CFP. Captured on a Remidio FOP fundus camera. Image size 1659x2212
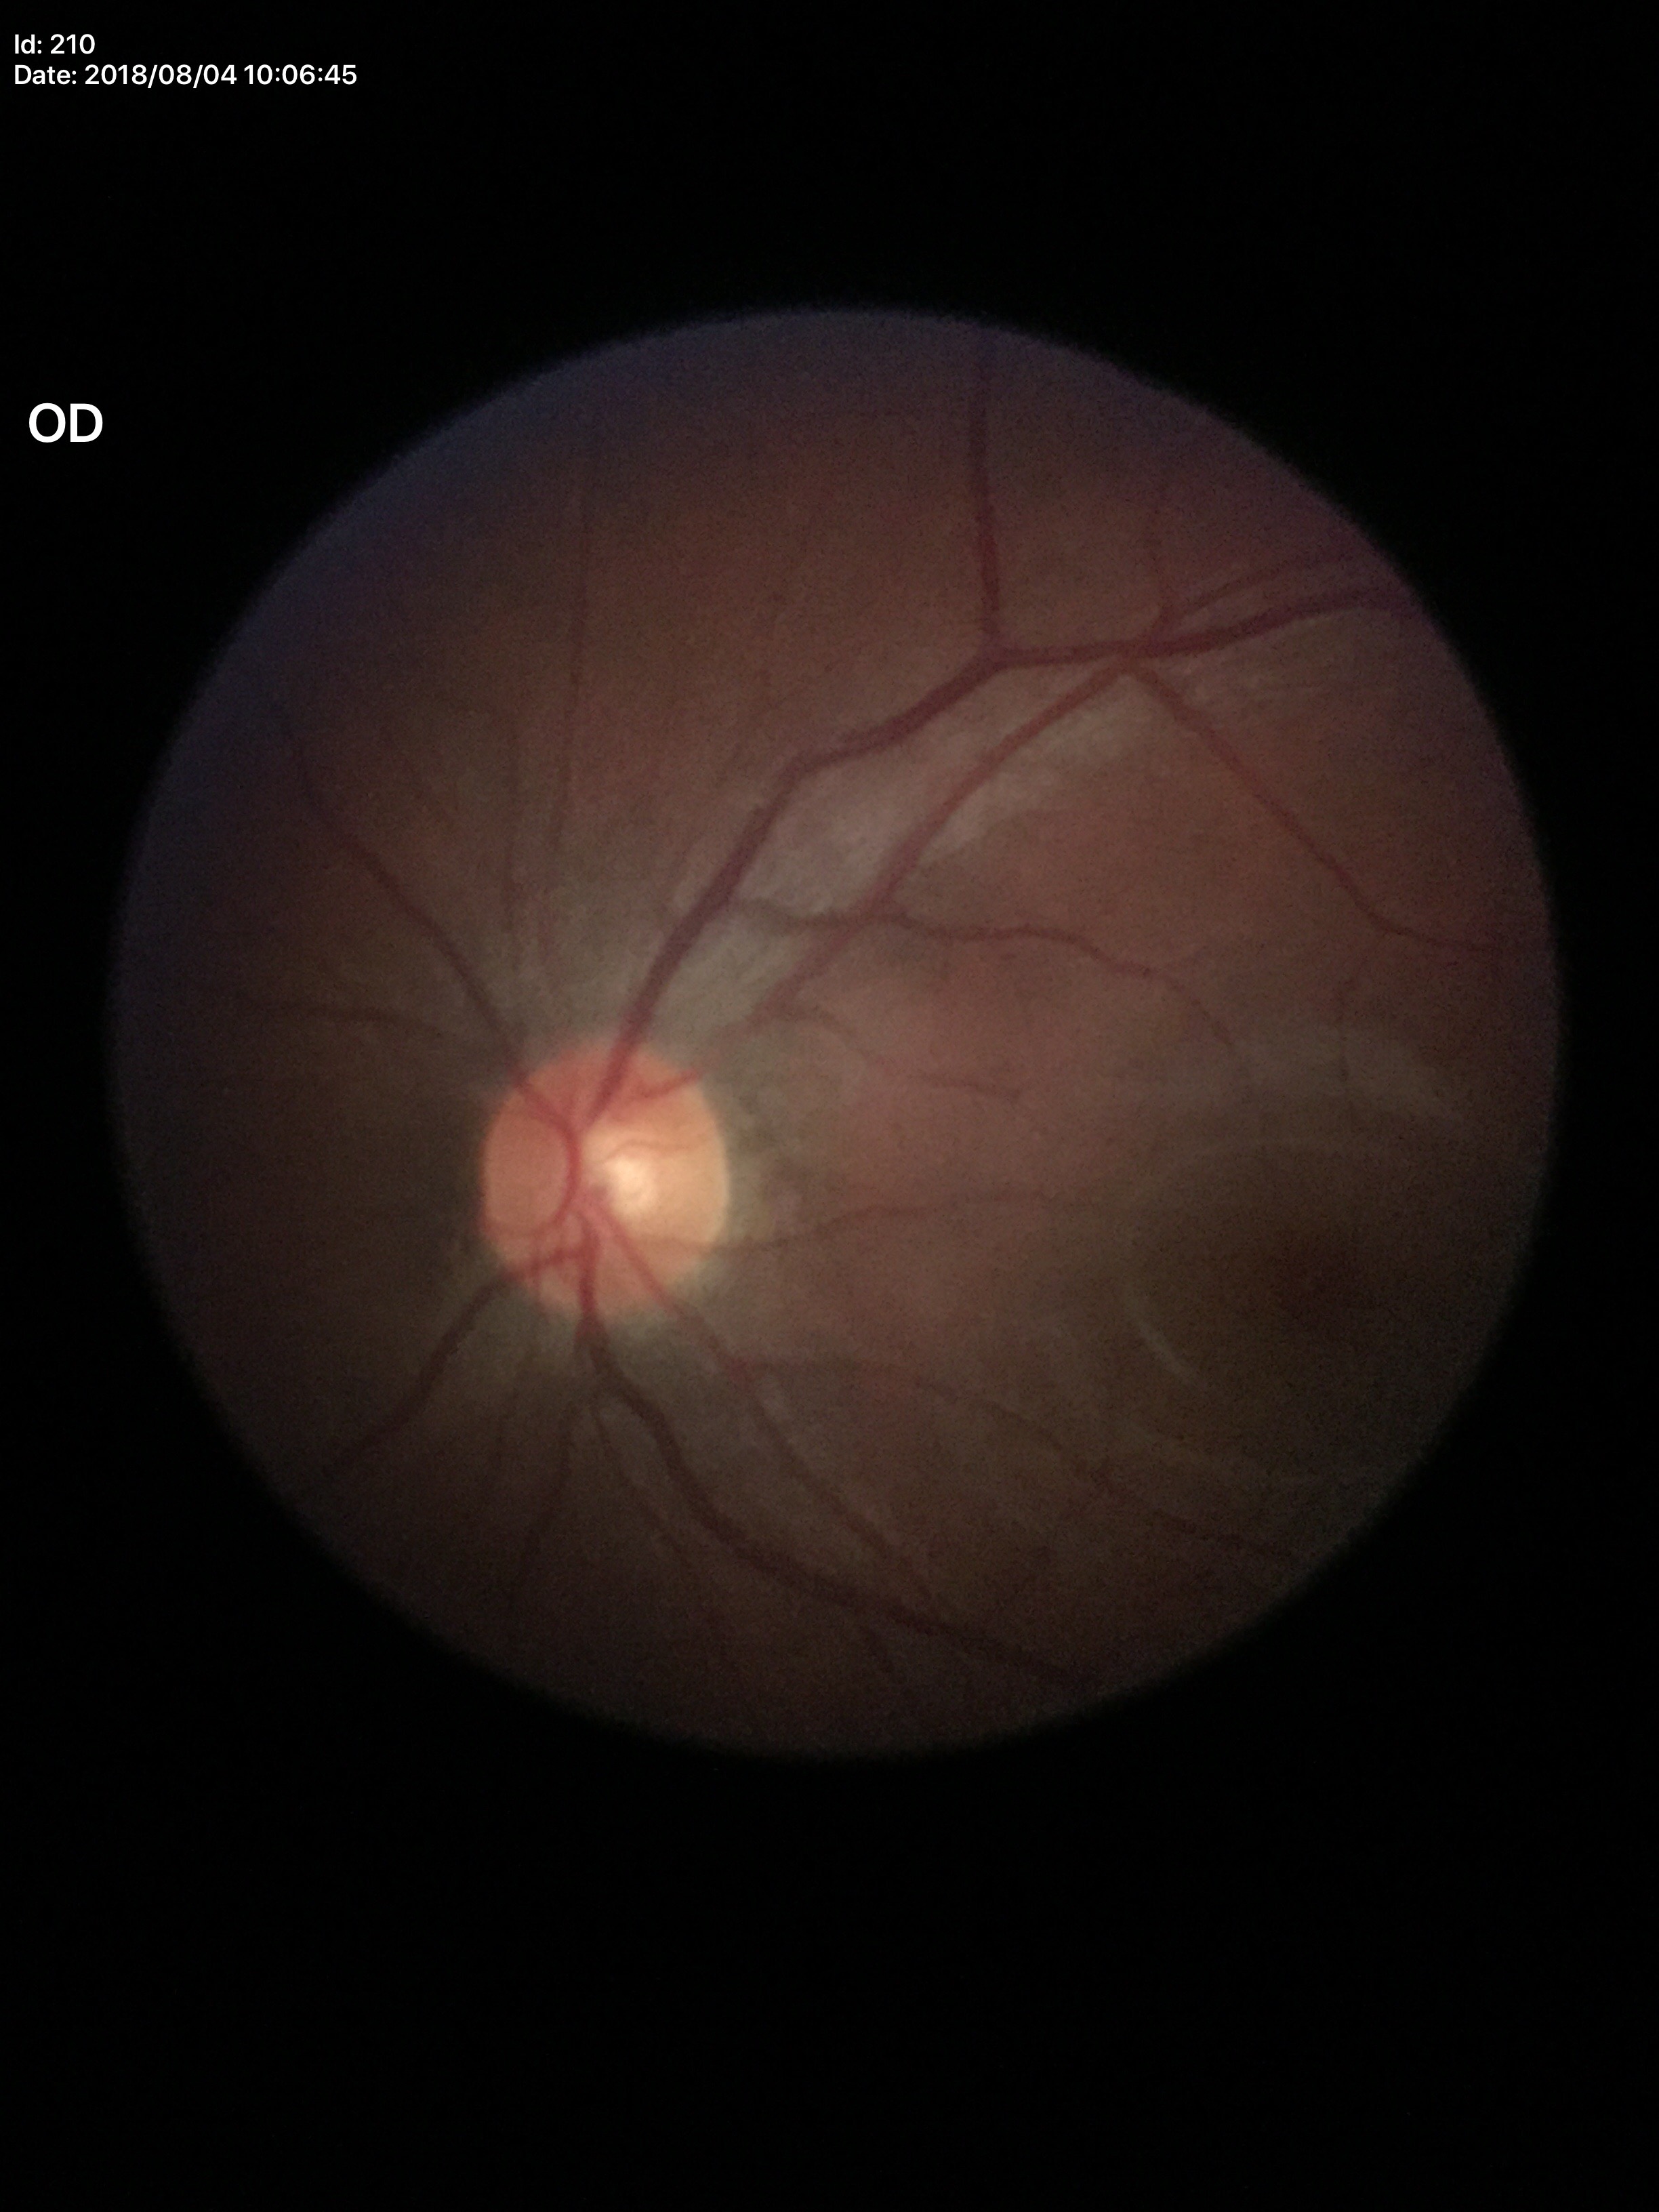

– ACDR — 0.29
– Glaucoma decision — negative (all 5 graders called normal)
– VCDR — 0.53